Infant wide-field retinal image:
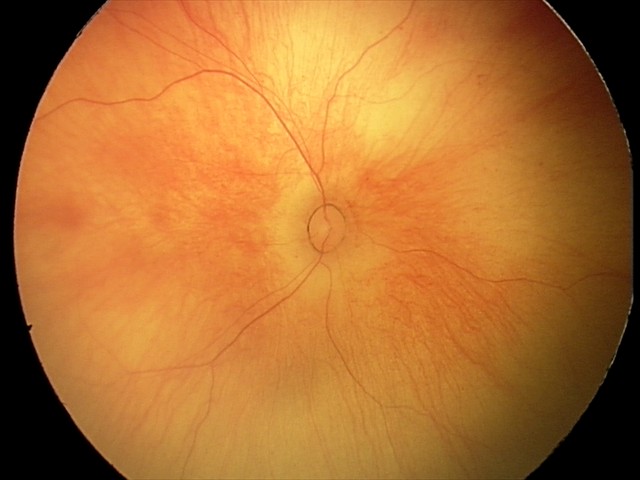 Screening examination diagnosed as physiological.